FOV: 45 degrees · 1932 by 1932 pixels · color fundus image:
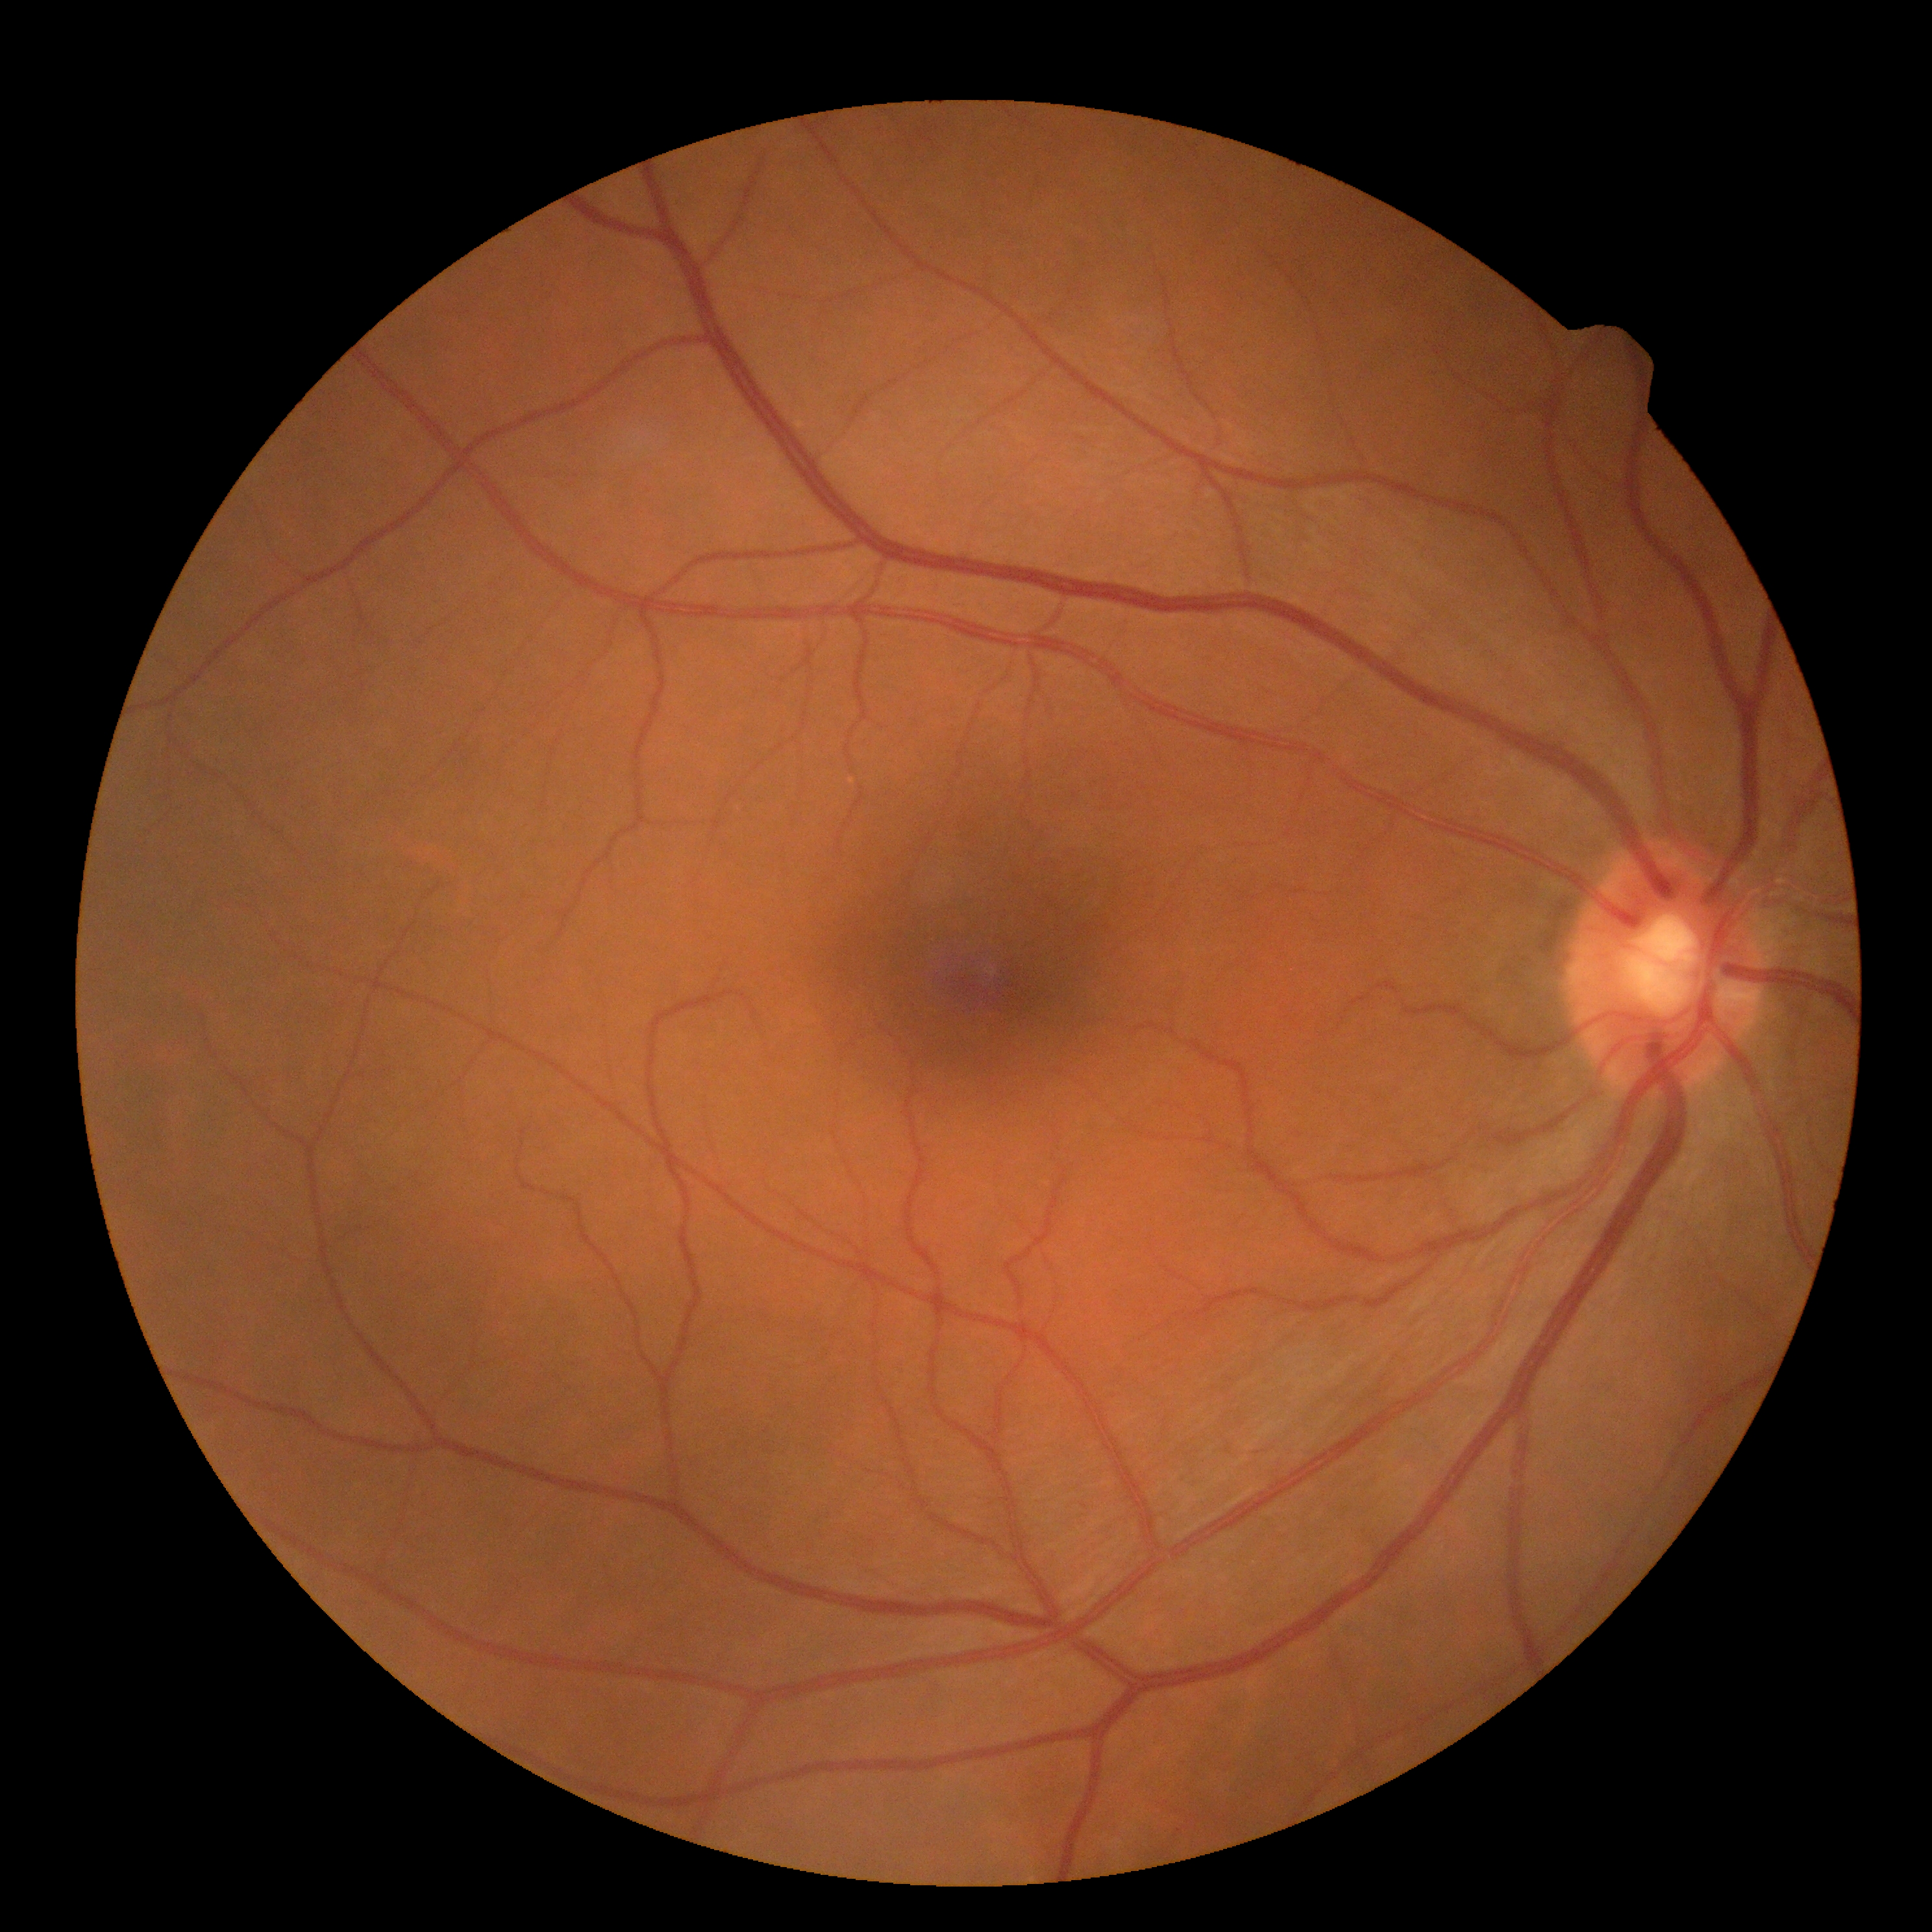 Diabetic retinopathy (DR) is no apparent retinopathy (grade 0).